45° FOV; retinal fundus photograph.
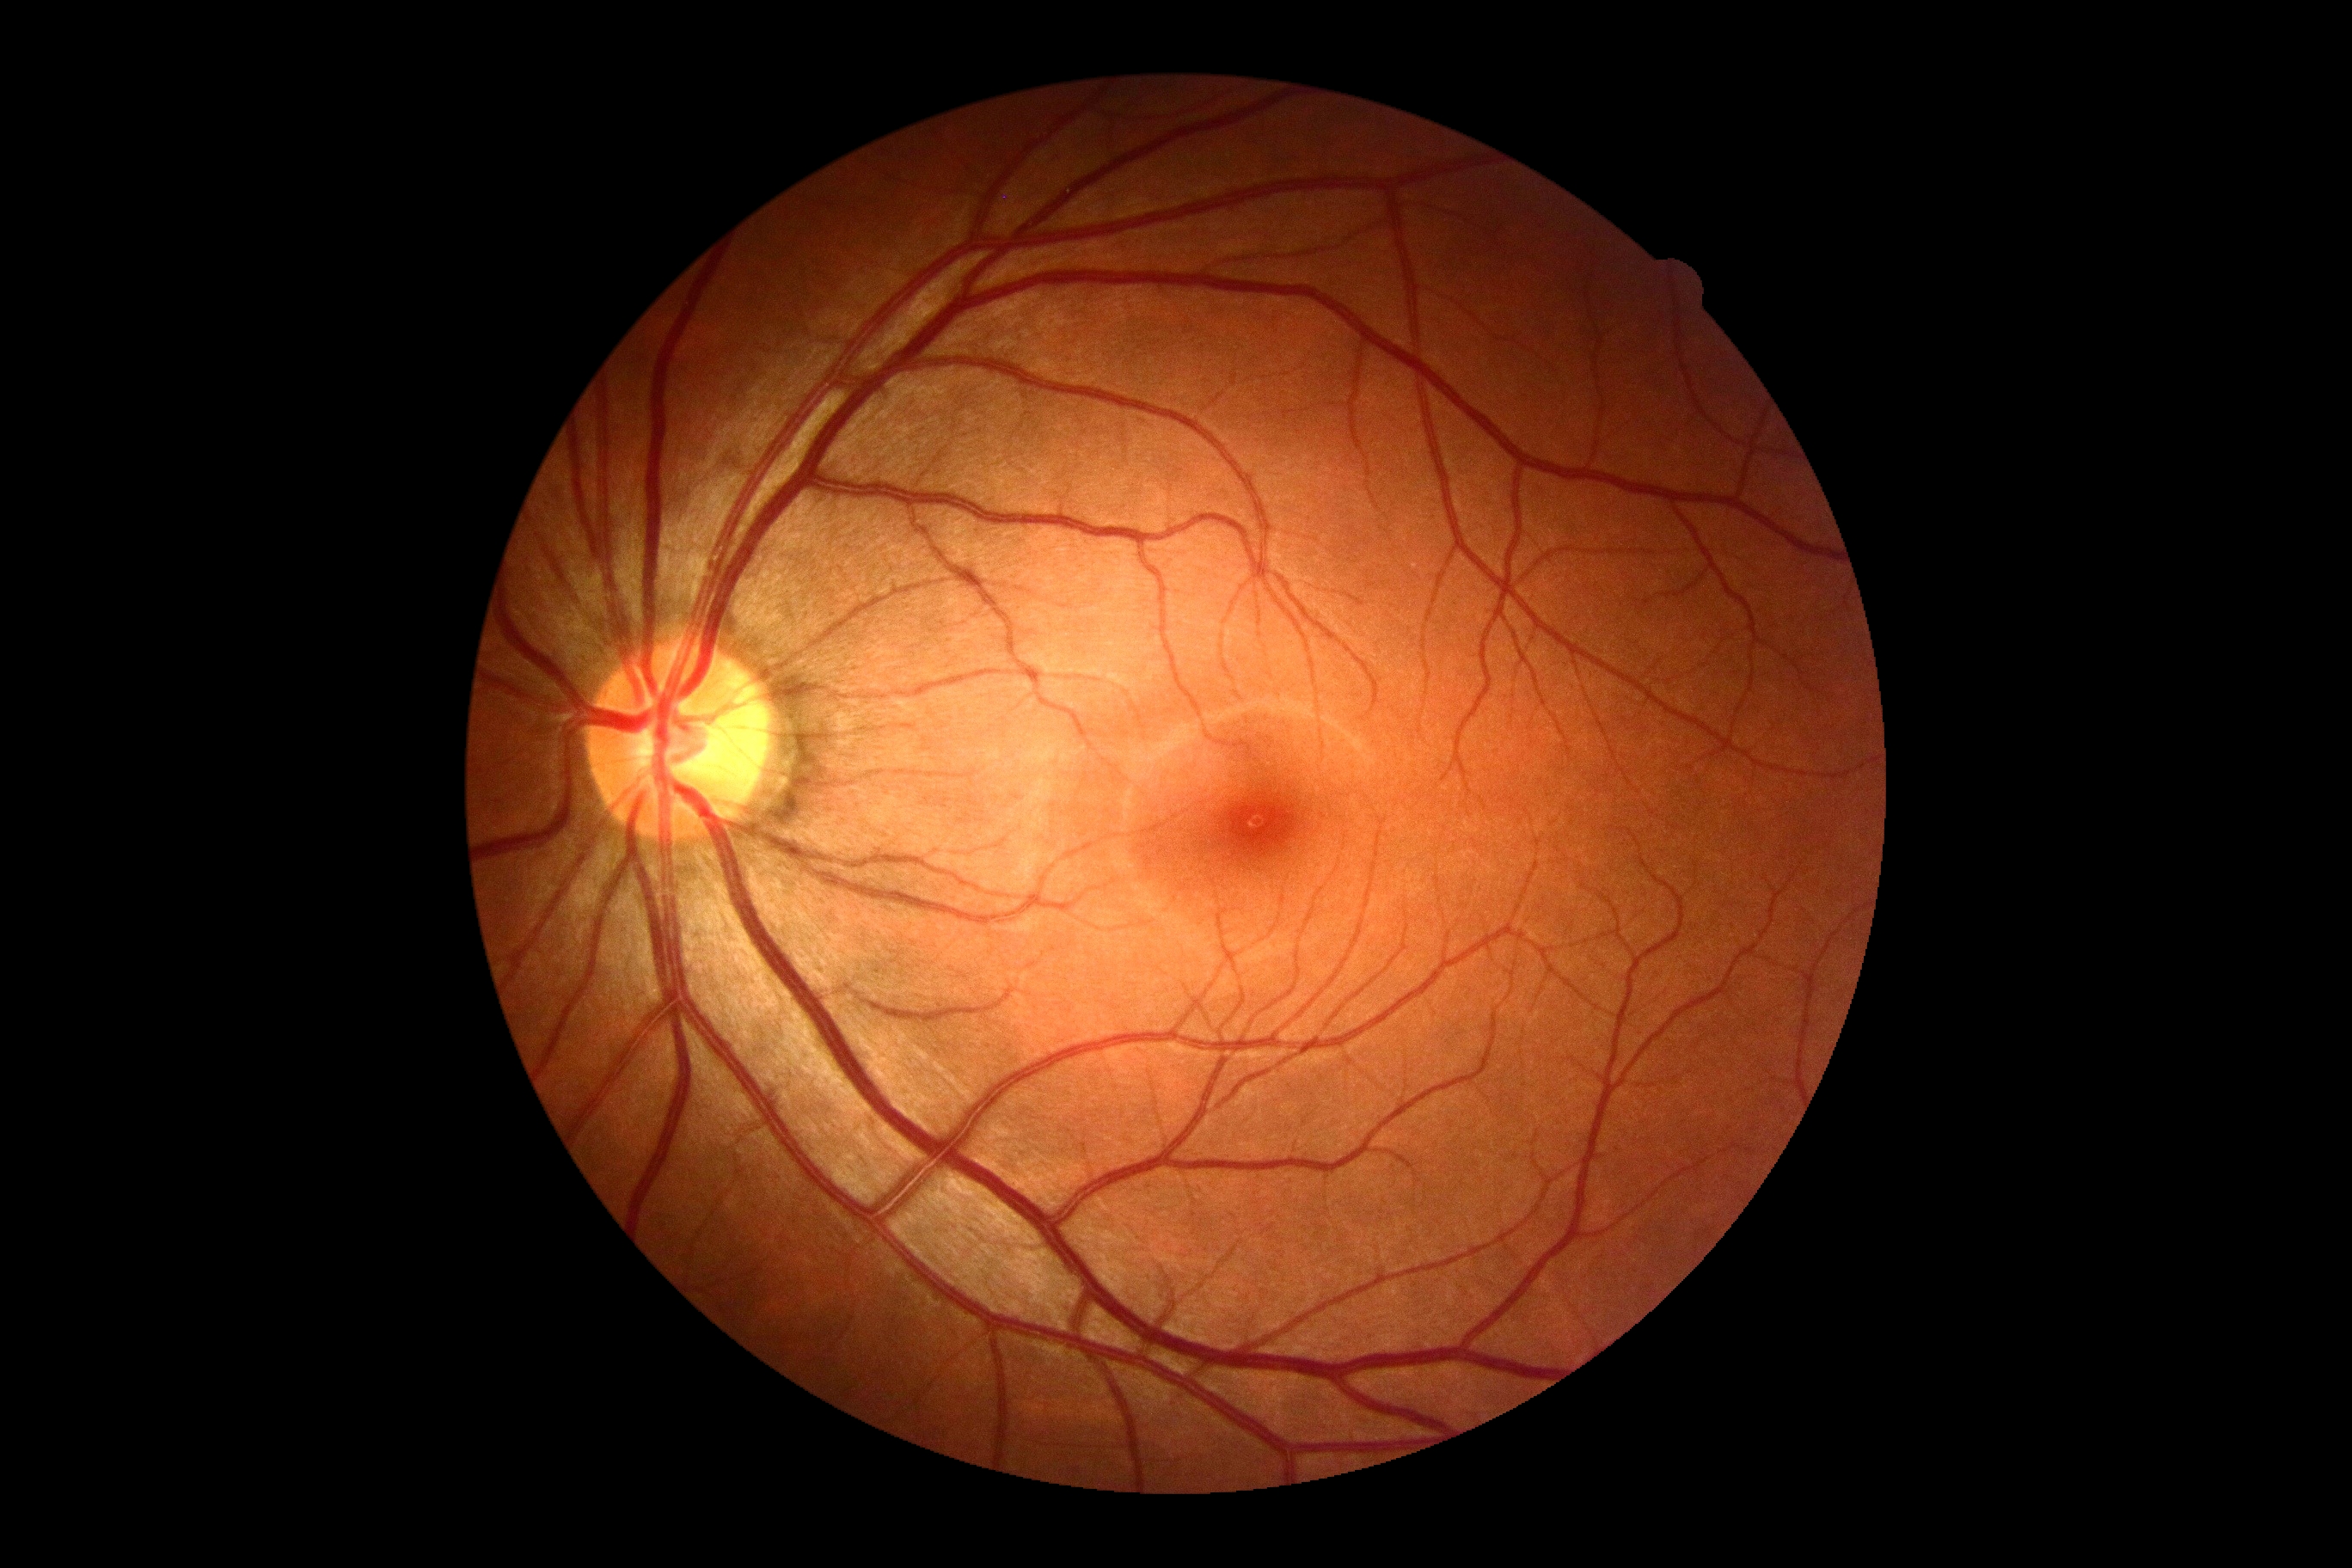
DR impression=no apparent DR; DR grade=no apparent retinopathy (0) — no visible signs of diabetic retinopathy.